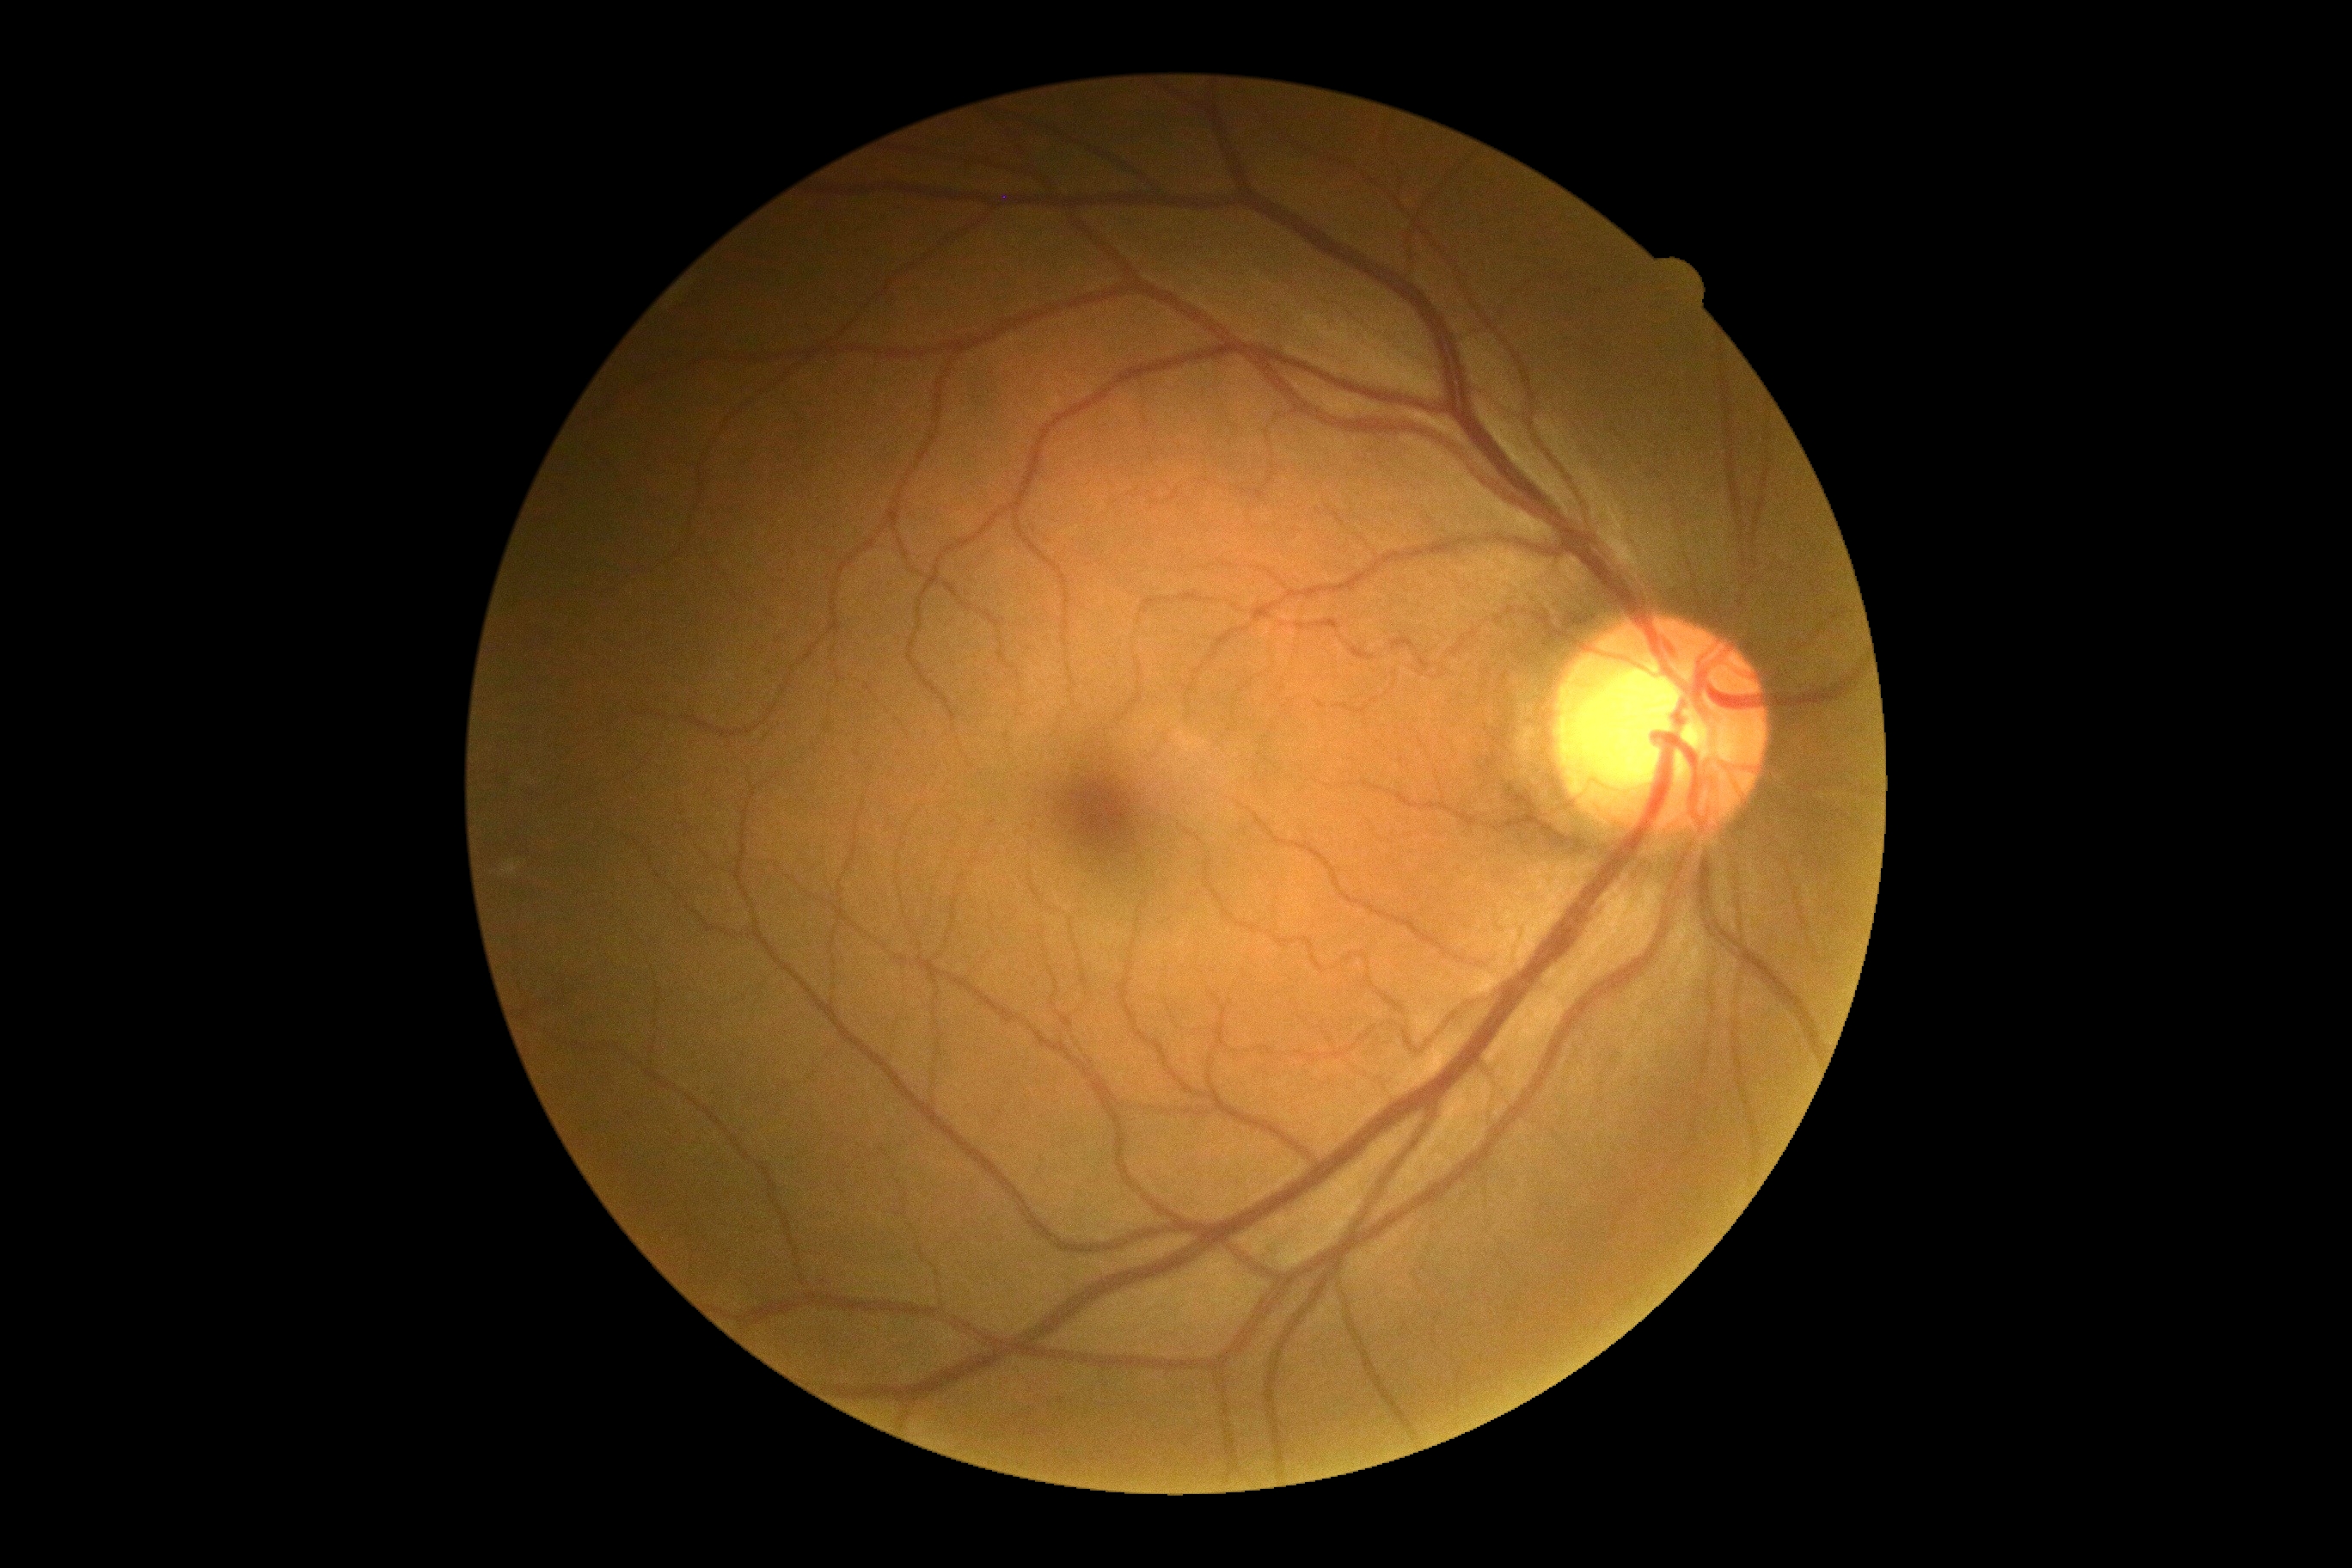 No DR findings.
Diabetic retinopathy (DR): no apparent retinopathy (grade 0).